Pediatric wide-field fundus photograph.
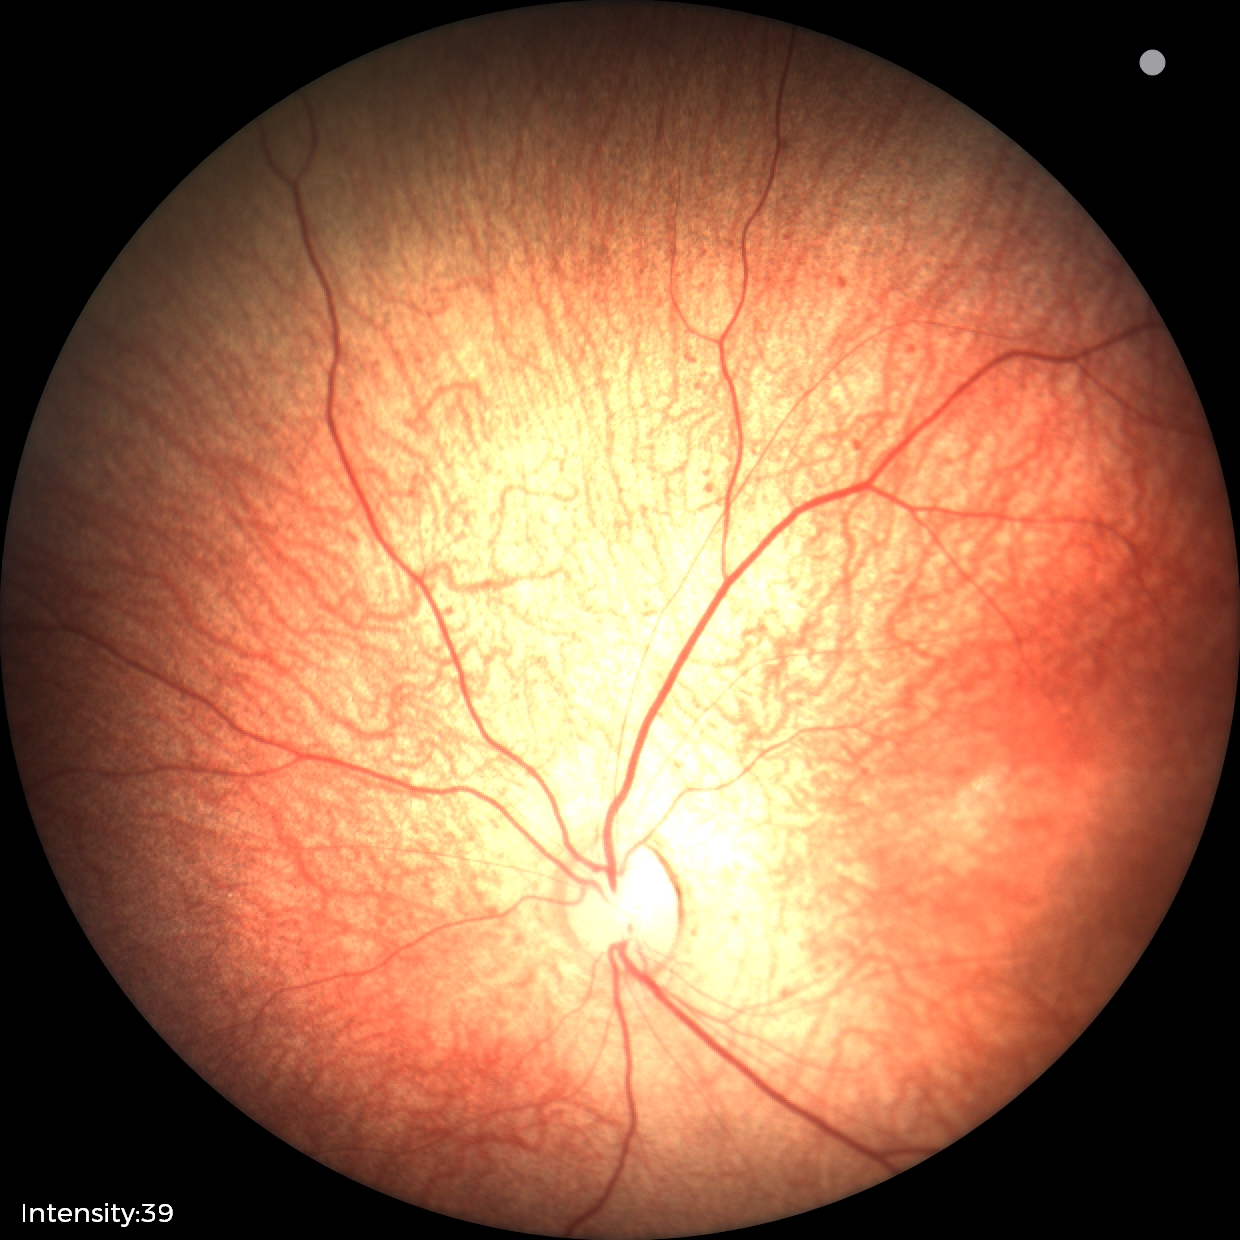

Physiological retinal appearance for postconceptual age.